Modified Davis grading:
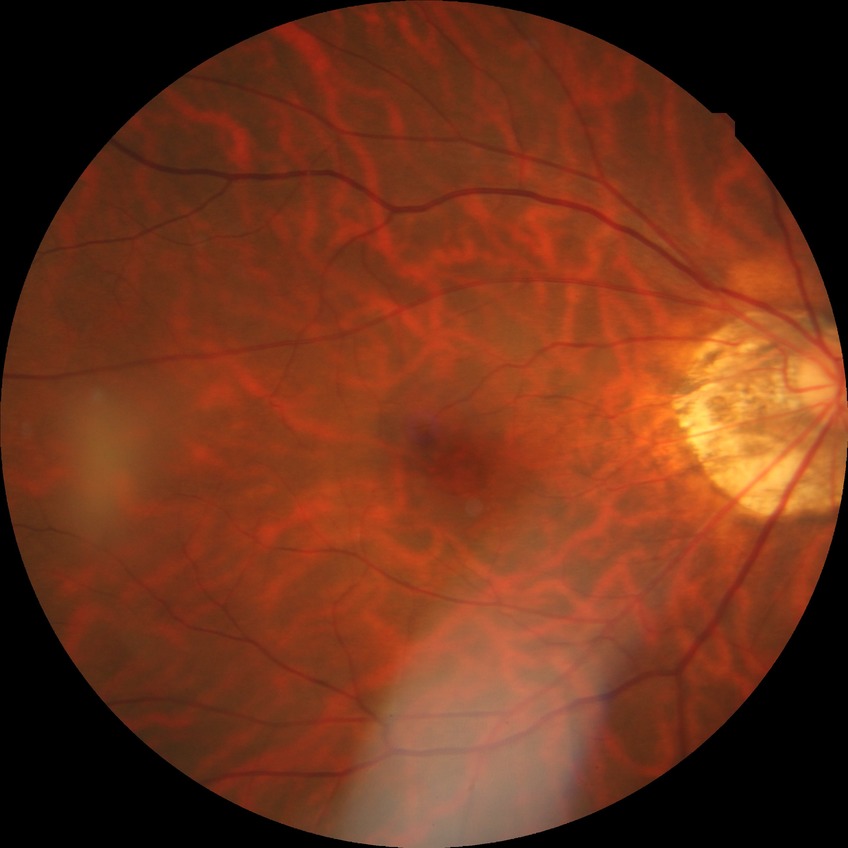
• diabetic retinopathy (DR): no diabetic retinopathy (NDR)